2346 by 1568 pixels, color fundus image, 45° field of view: 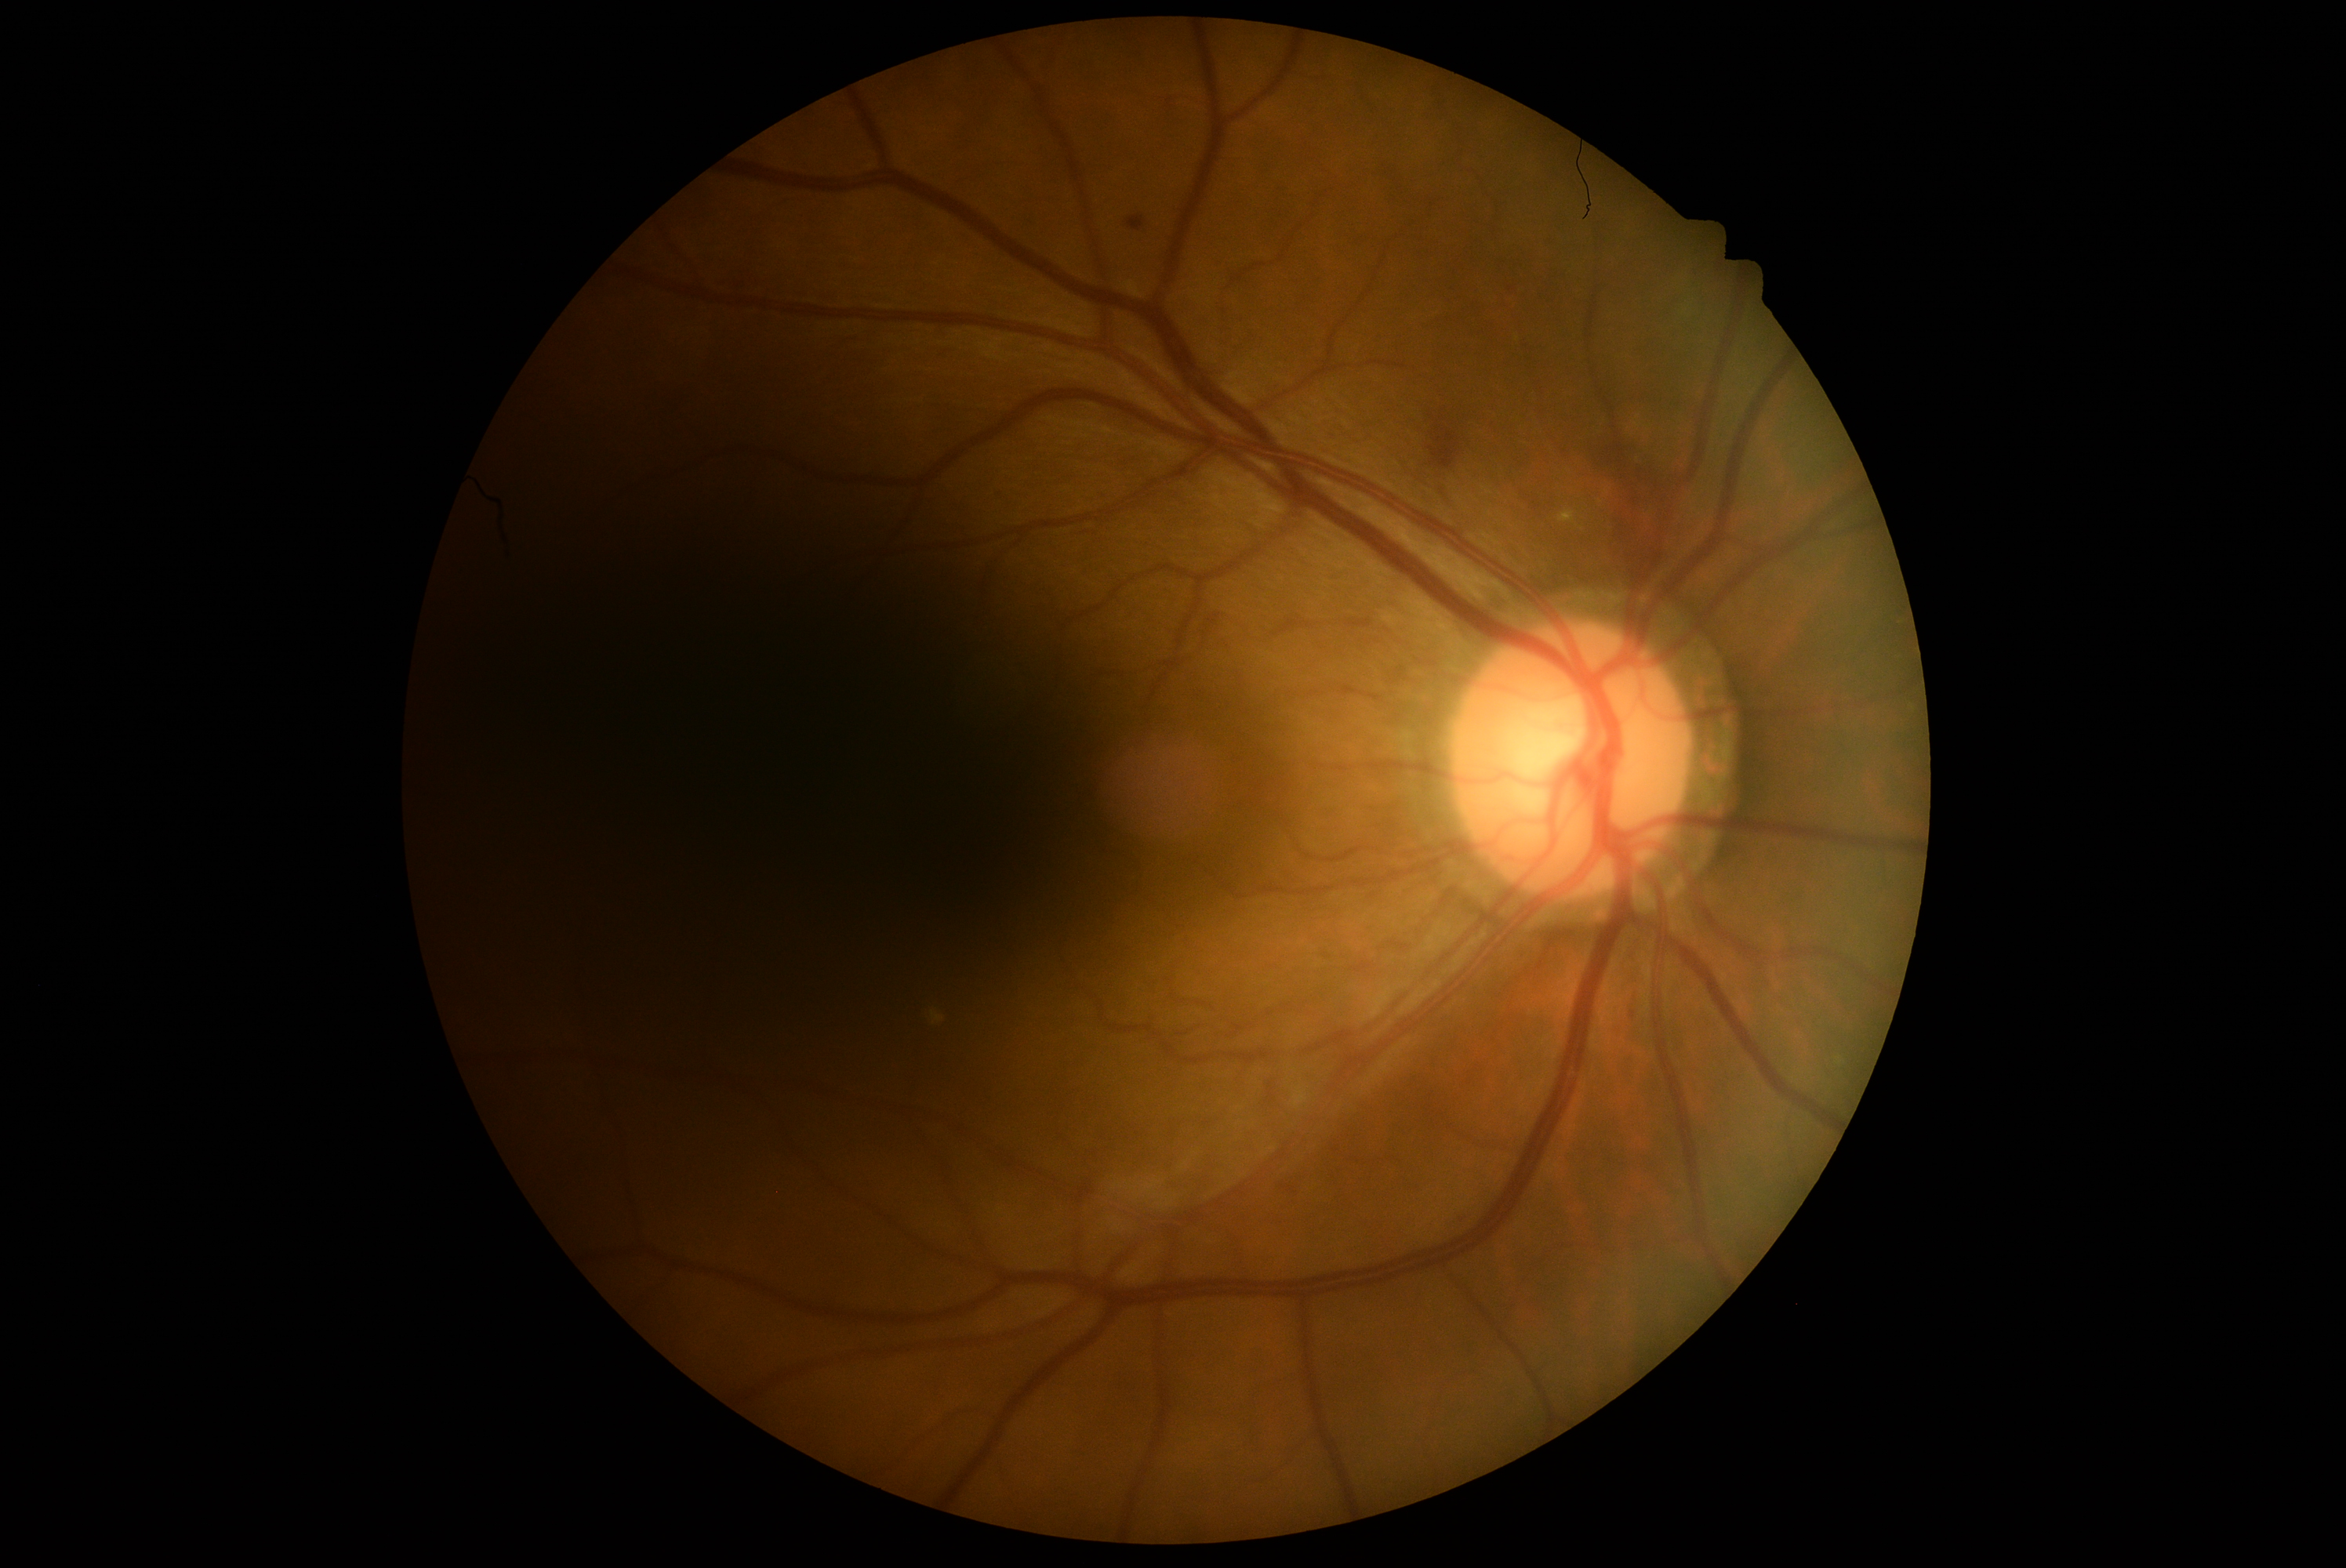
Diabetic retinopathy (DR) is moderate NPDR (grade 2).